Color fundus image; 2048 by 1536 pixels
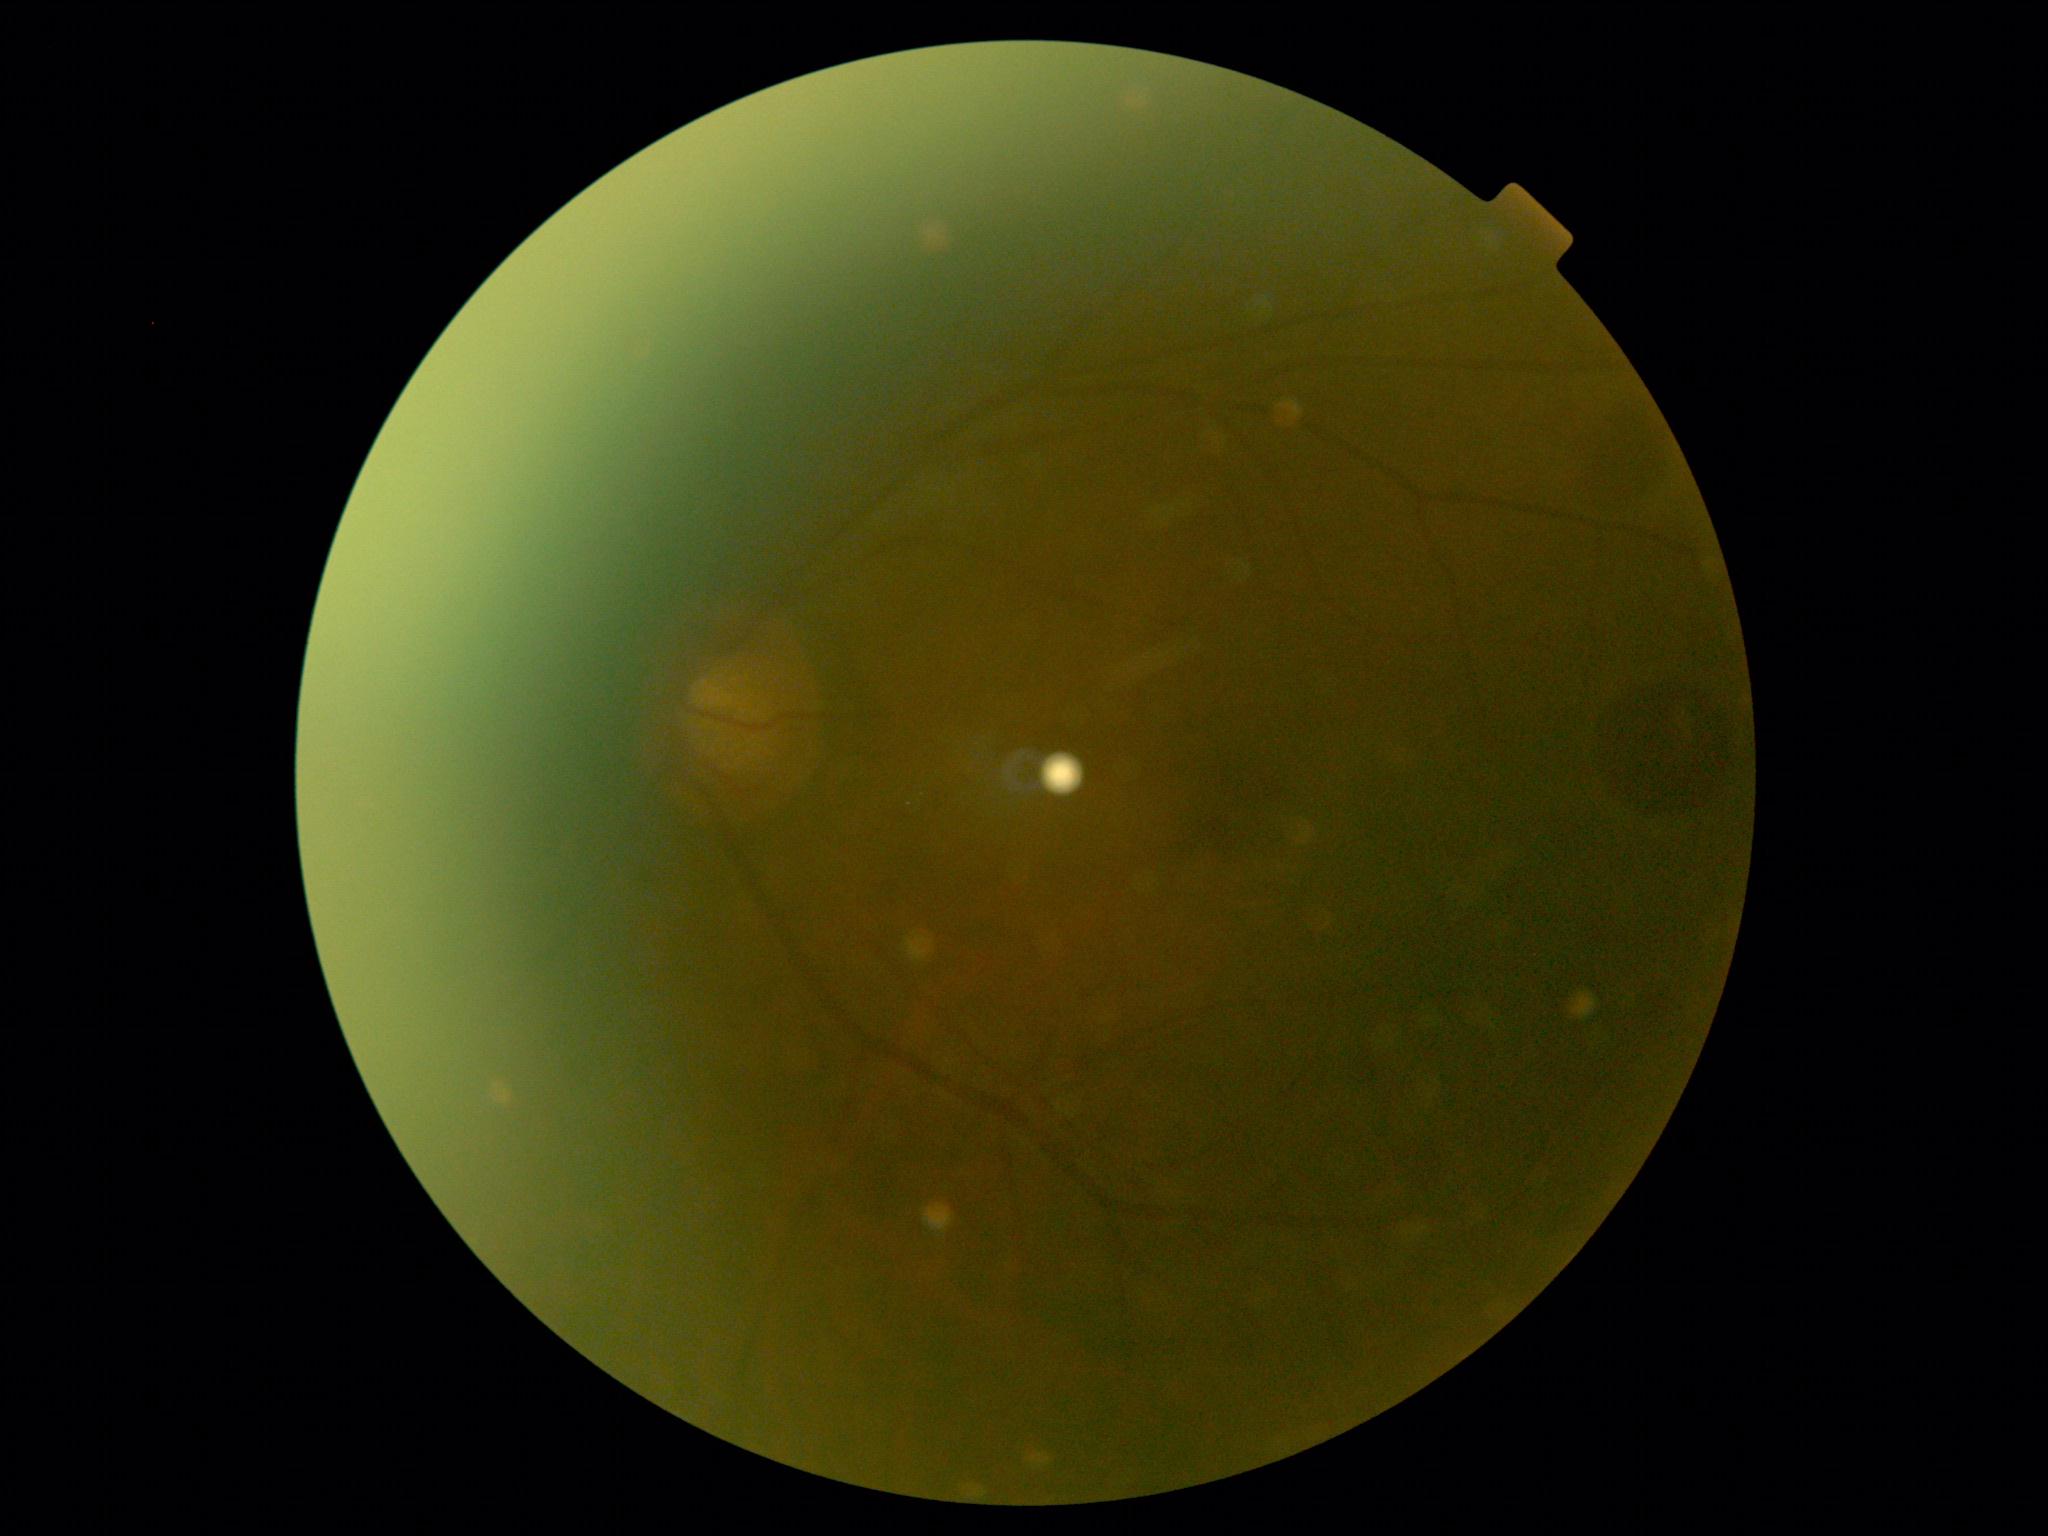

{"dr_grade": "ungradable", "quality": "insufficient"}